Color fundus photograph · 45° FOV · image size 2212x1659
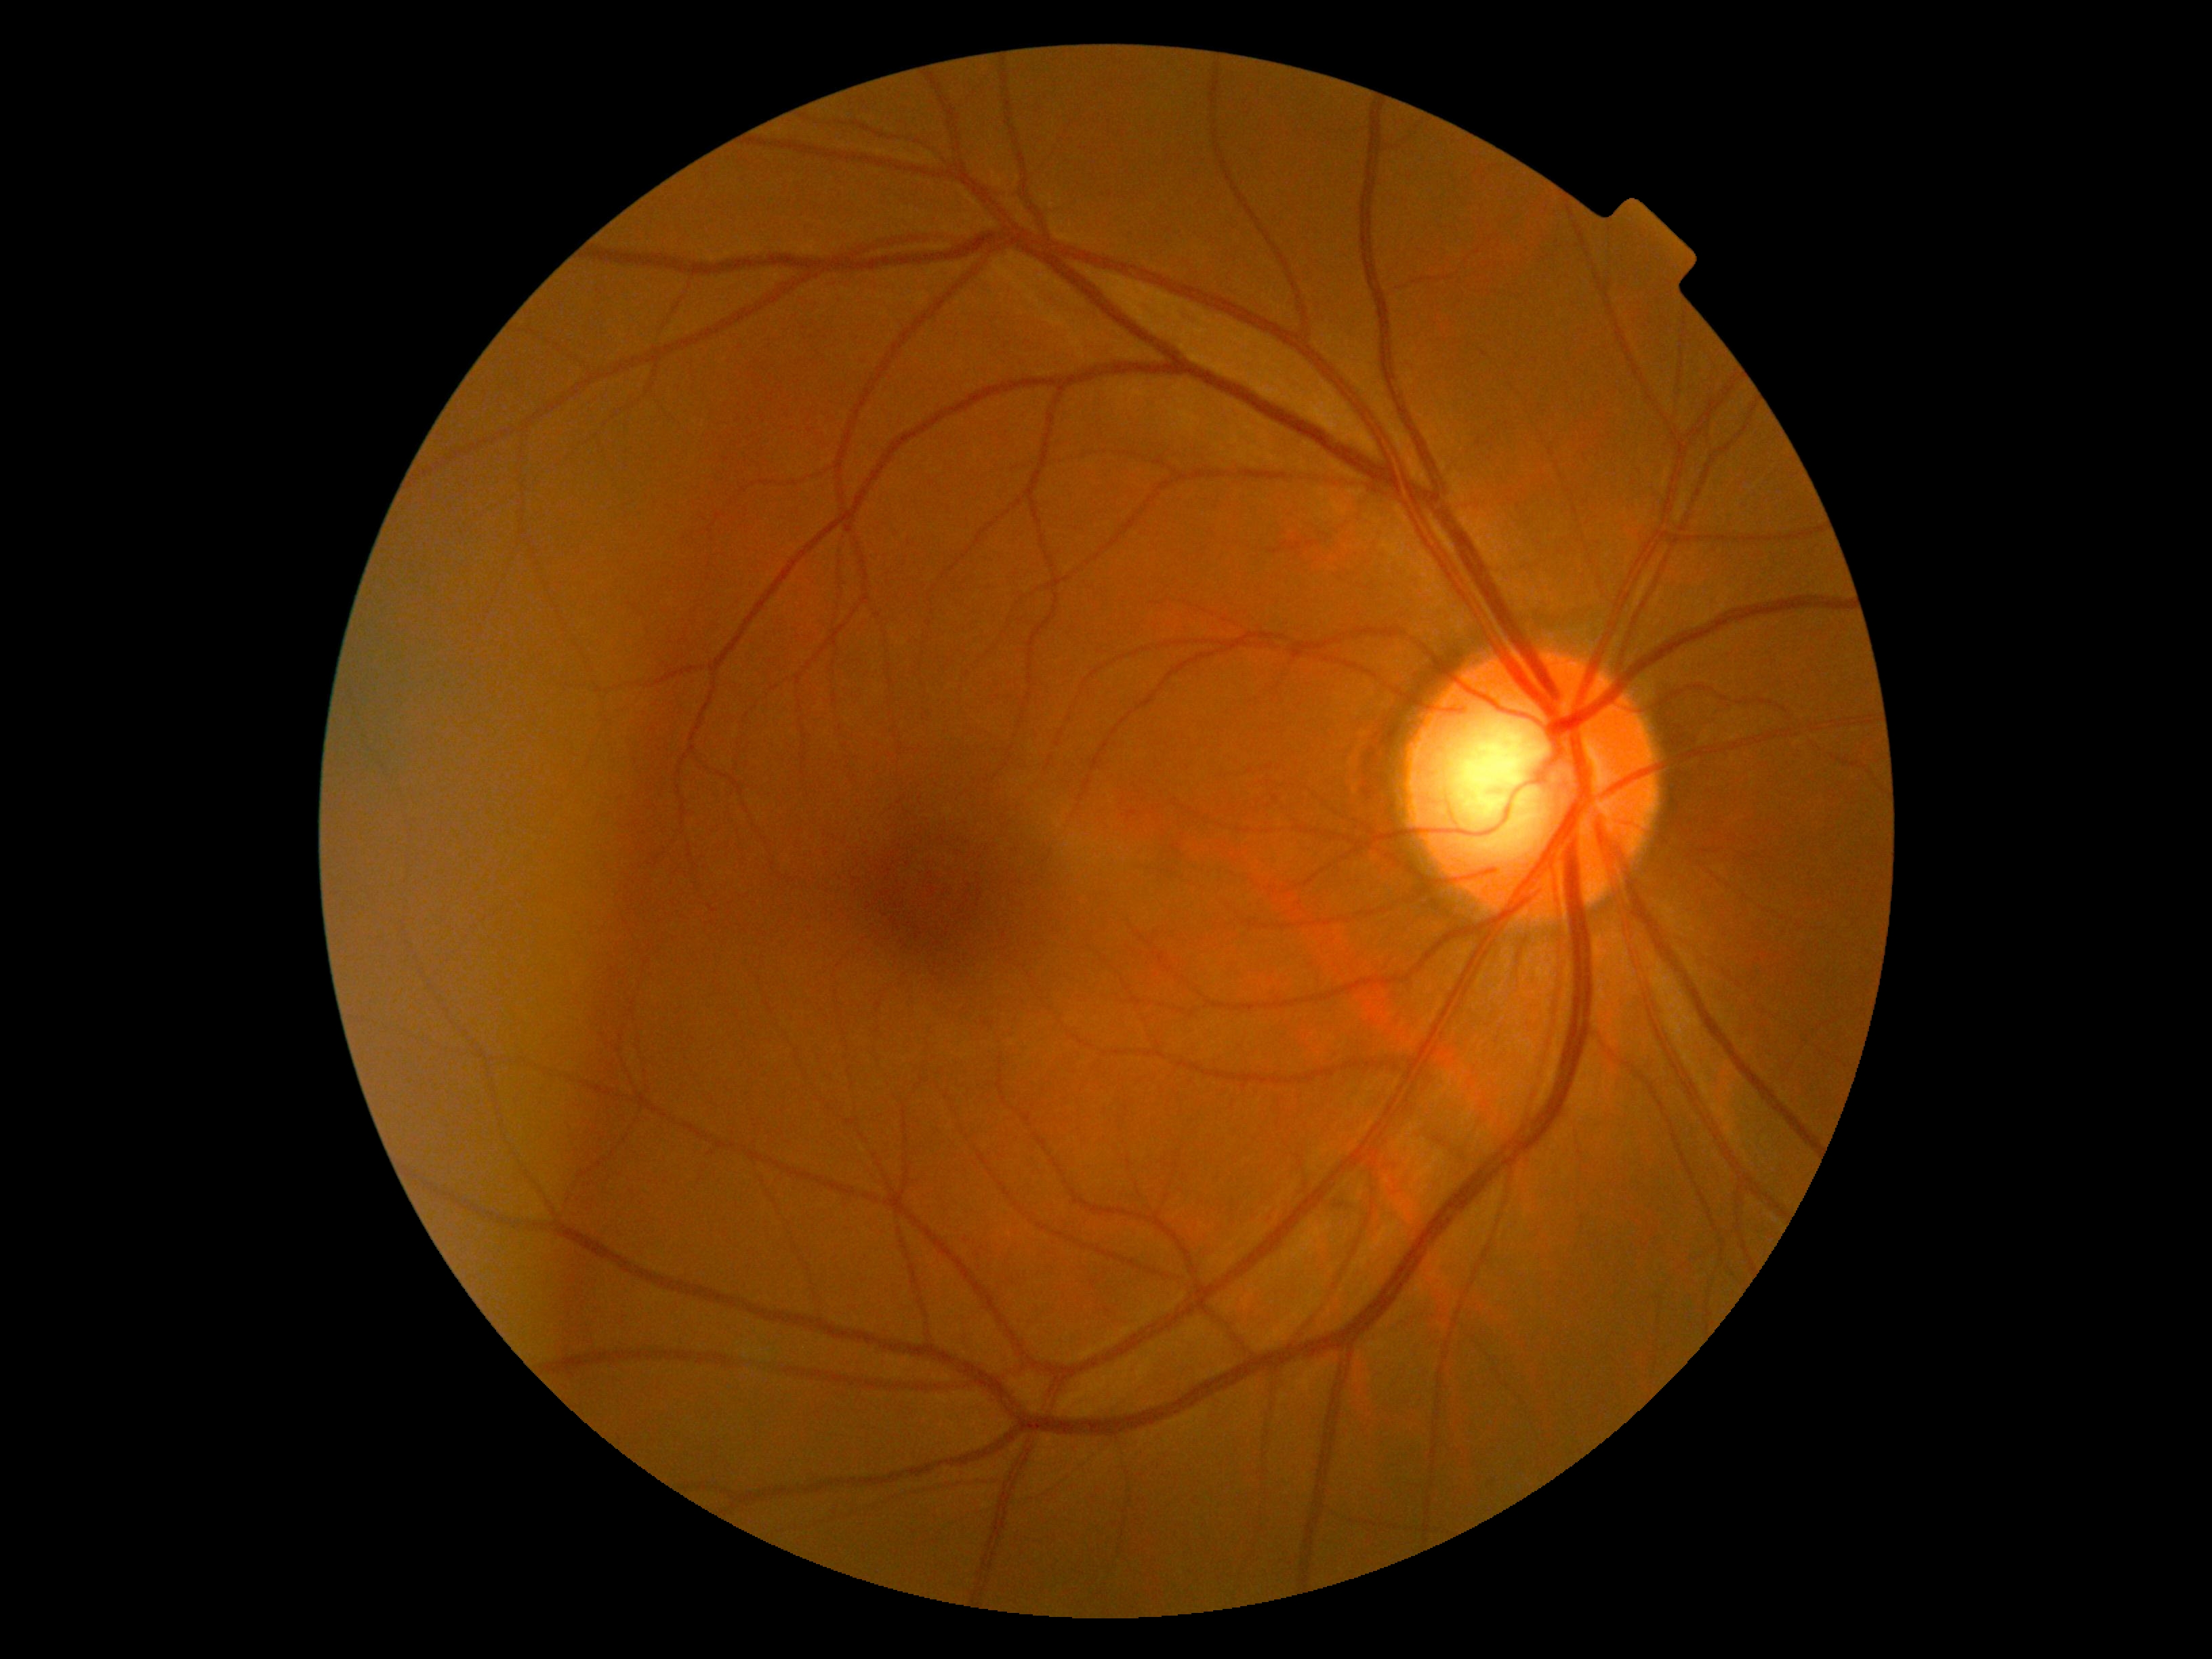

Retinopathy: grade 0 (no apparent retinopathy).